ONH-centered crop from a color fundus image. Mydriatic acquisition
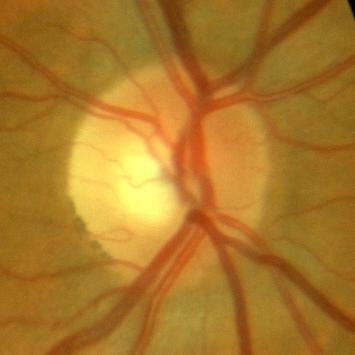 Showing no glaucomatous findings.